Fundus photo. Image size 2184x1690. 45° field of view.
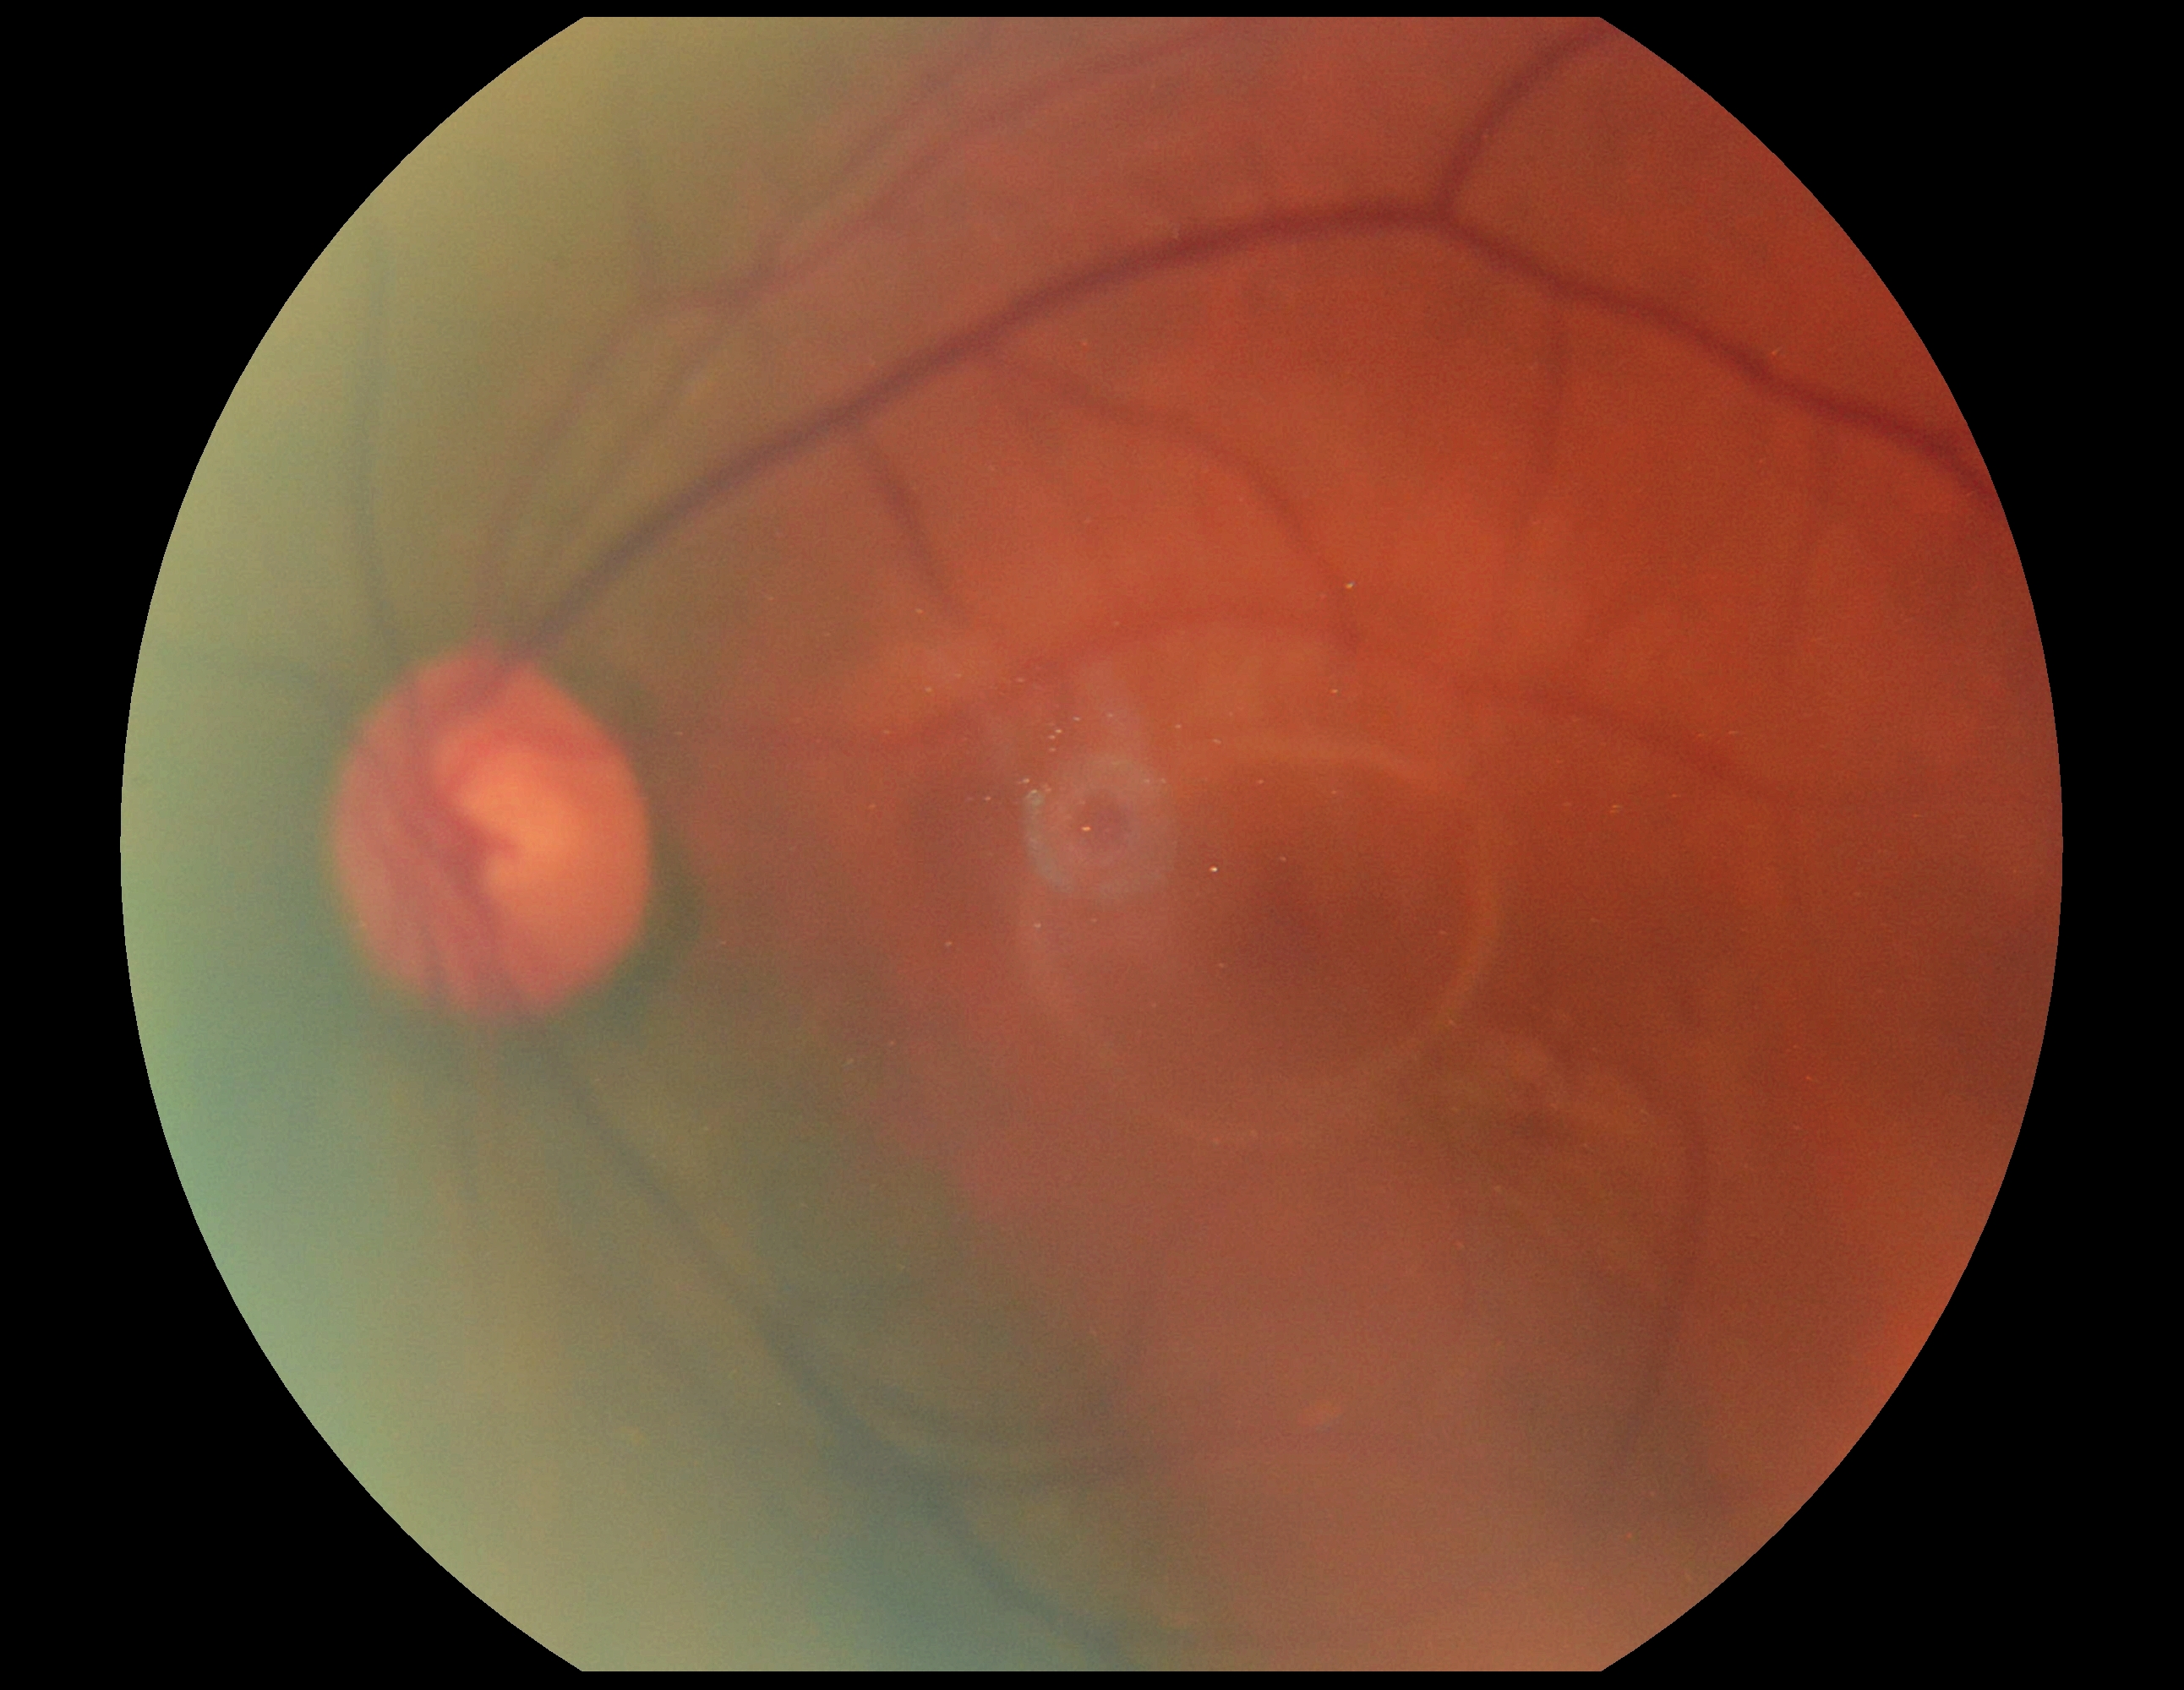

Diabetic retinopathy (DR): grade 0 (no apparent retinopathy).